1659x2212: 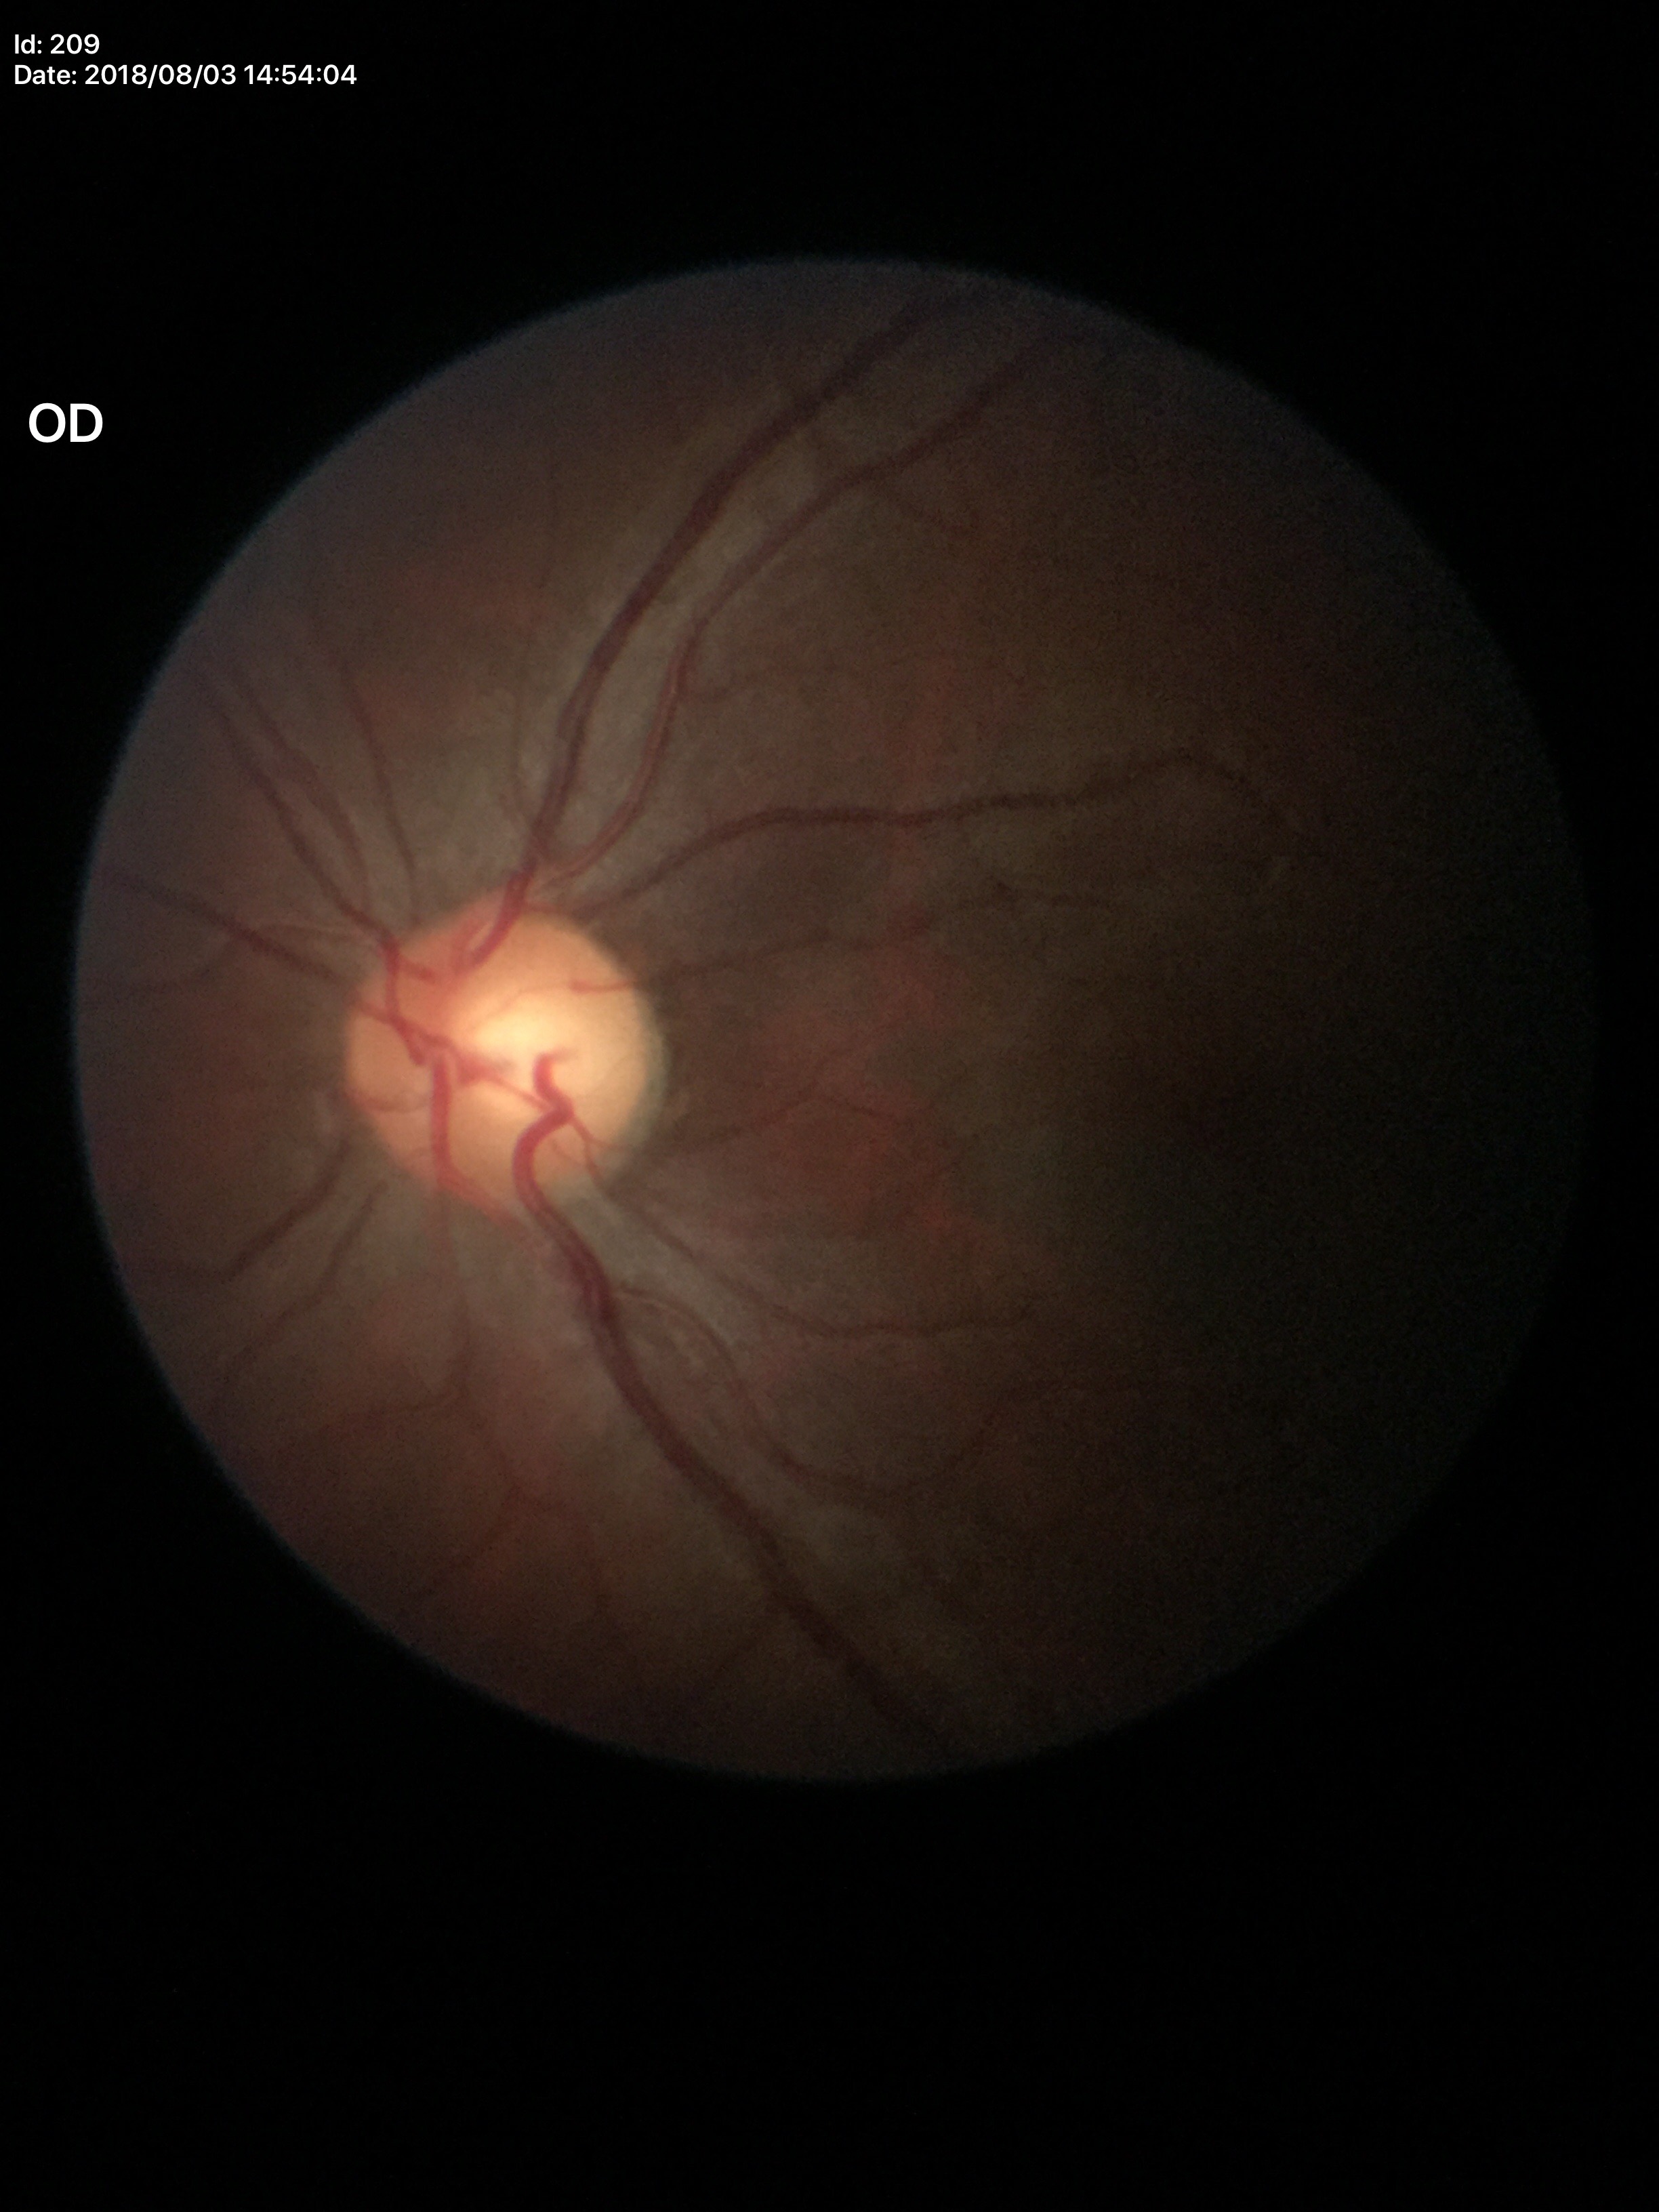
Area CDR (ACDR) is 0.31. Glaucoma screening impression: not suspect. Vertical C/D ratio (VCDR): 0.55.